Retinal fundus photograph · 45° FOV.
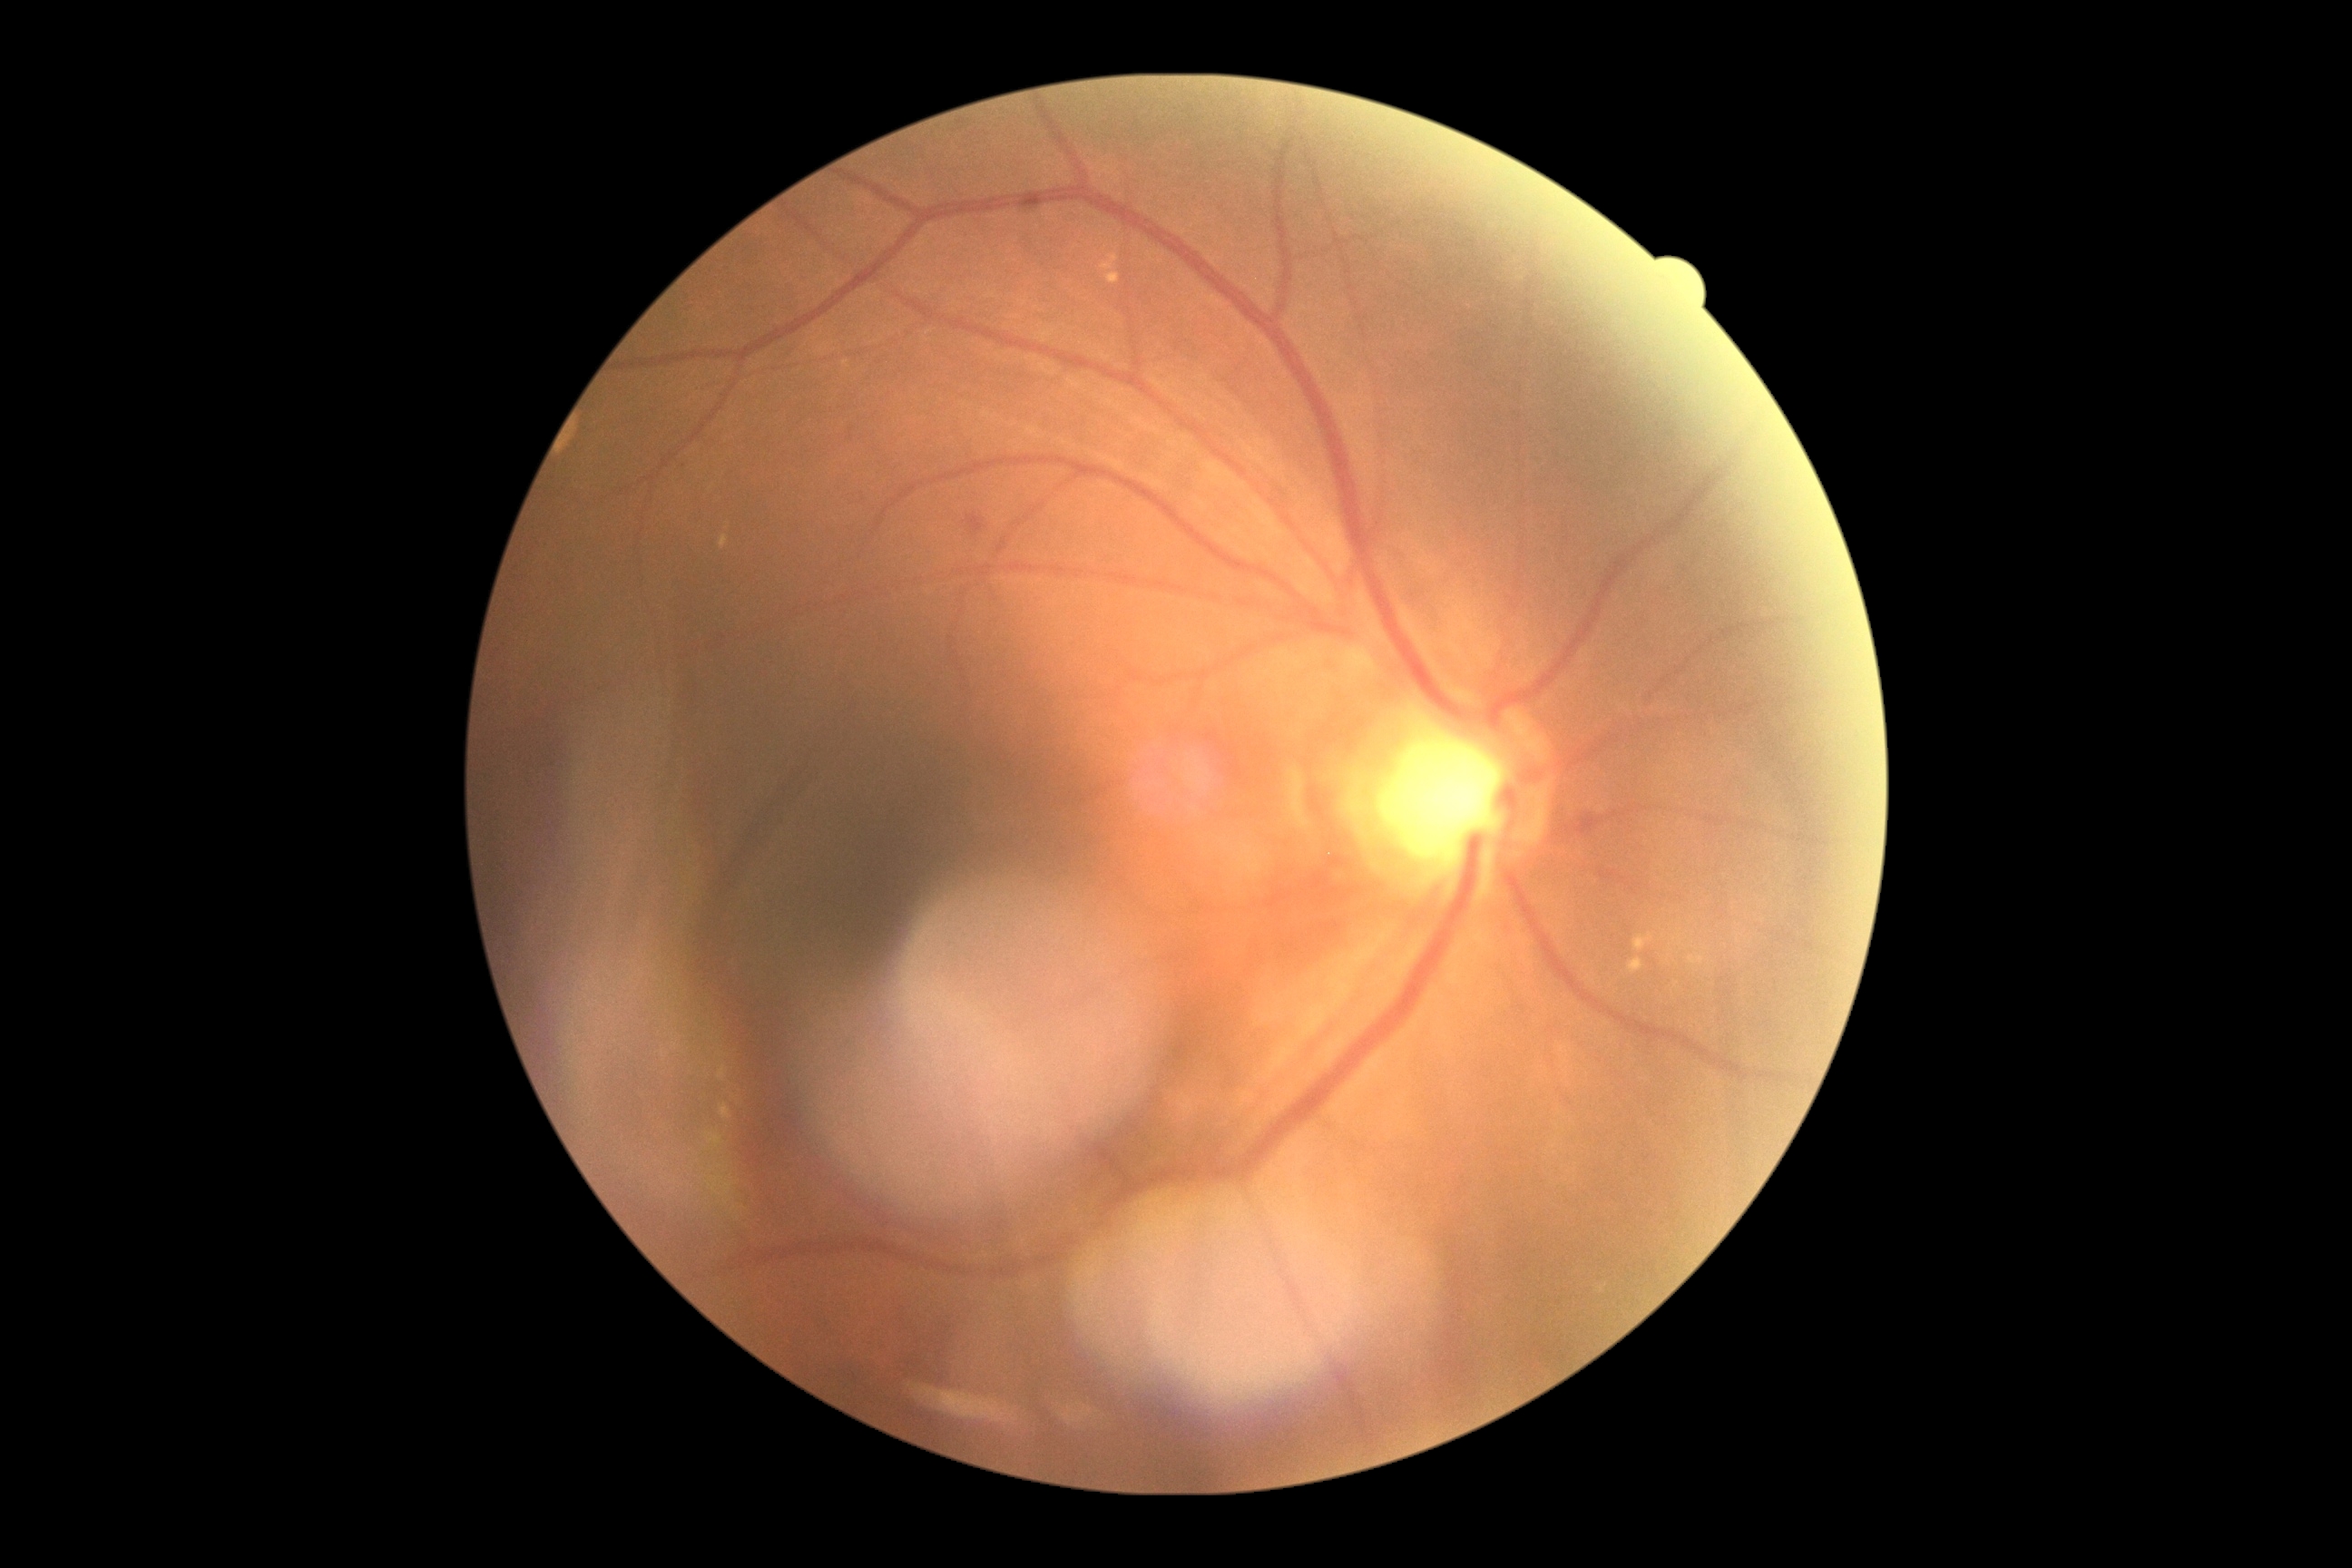 Retinopathy is moderate non-proliferative diabetic retinopathy (grade 2).